Camera: NIDEK AFC-230 — 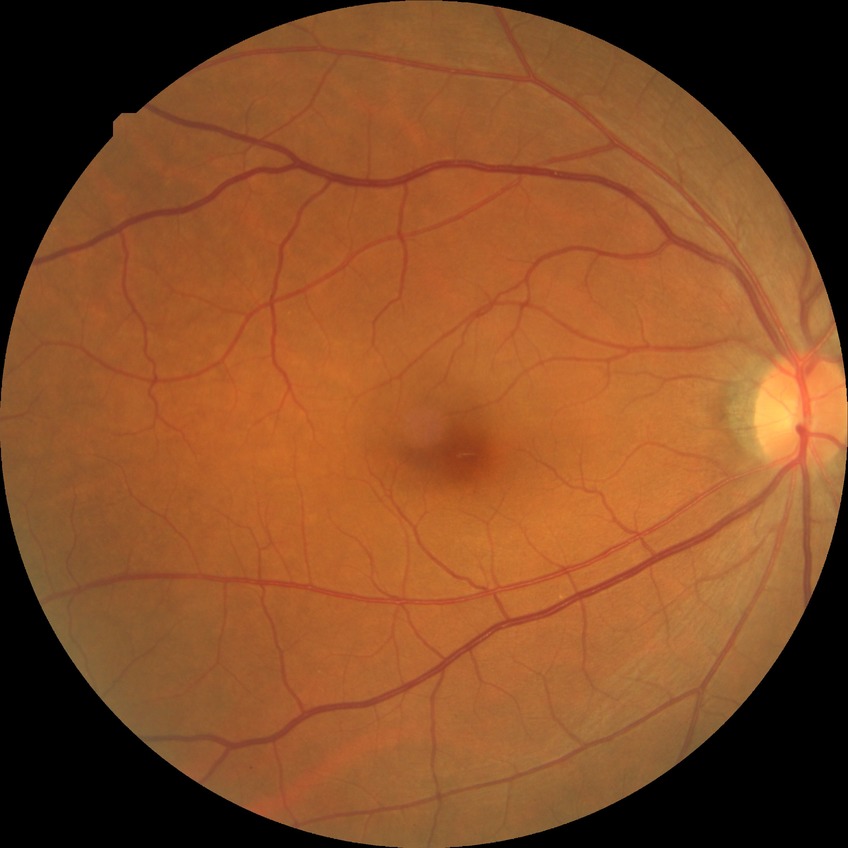 Modified Davis classification: no diabetic retinopathy.